2352x1568.
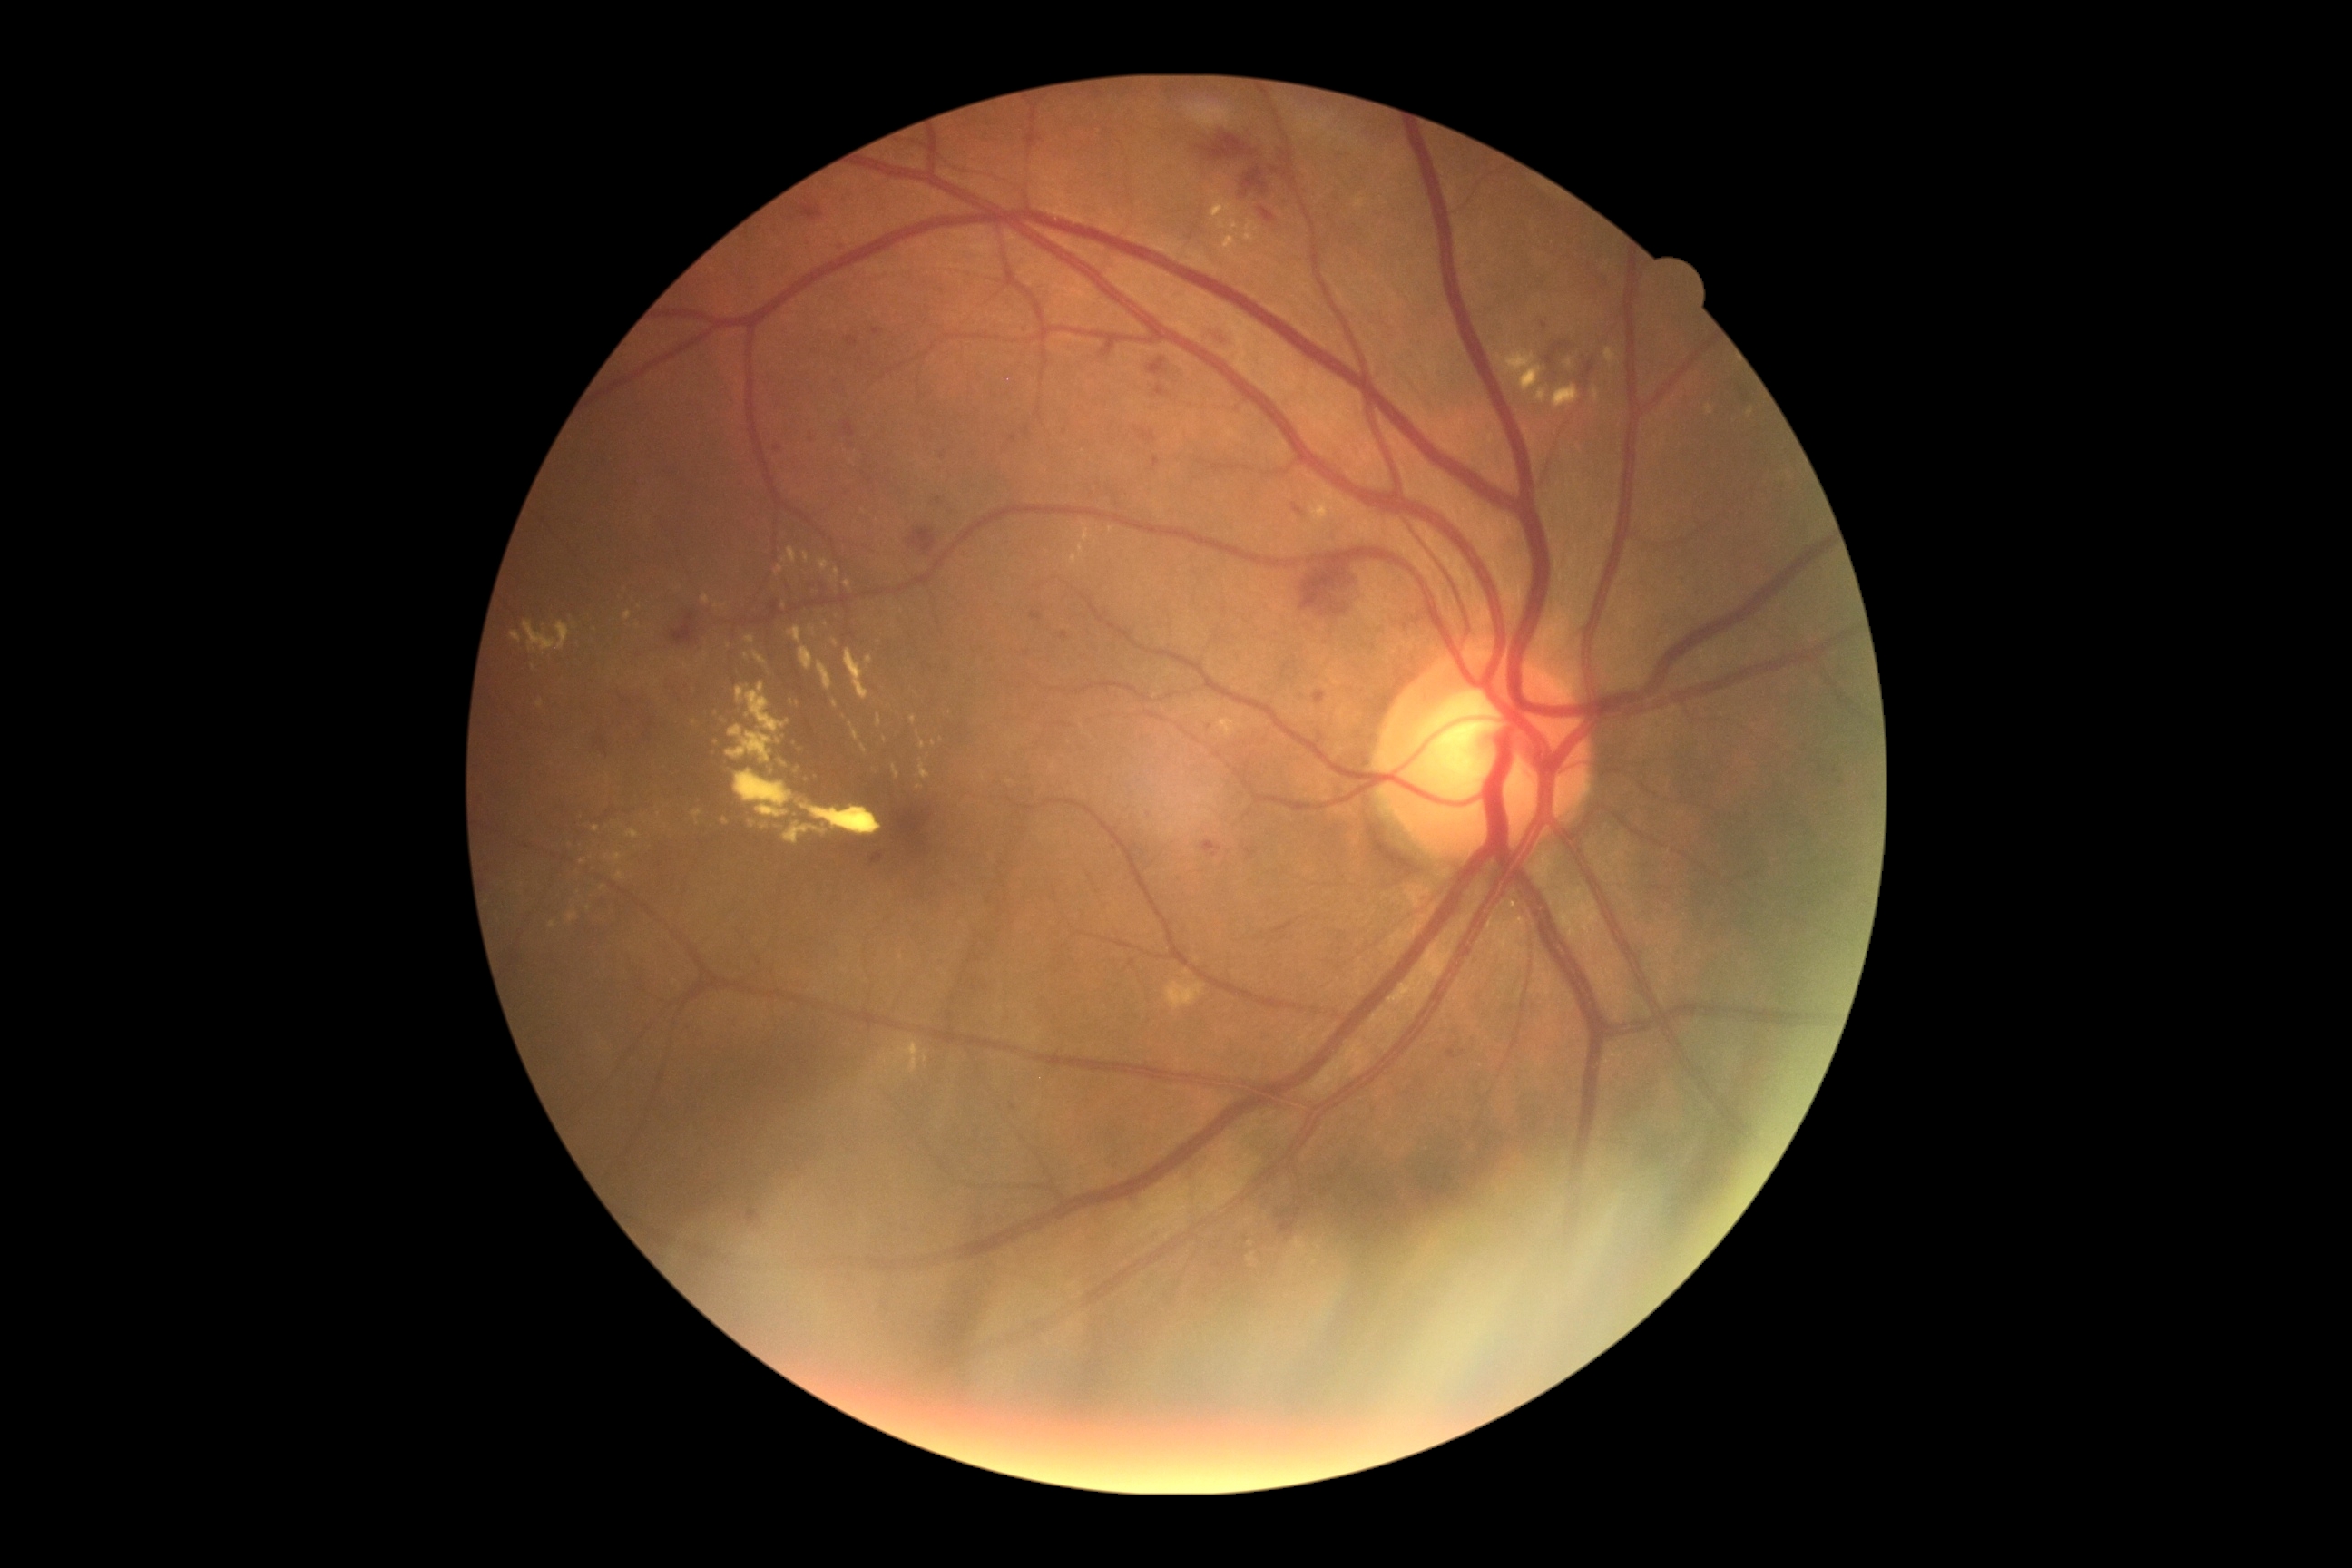 partial: true
dr_grade: 2
dr_grade_name: moderate NPDR
lesions:
  ex:
    - {"x1": 1224, "y1": 721, "x2": 1233, "y2": 734}
    - {"x1": 692, "y1": 810, "x2": 703, "y2": 827}
    - {"x1": 819, "y1": 560, "x2": 830, "y2": 573}
    - {"x1": 808, "y1": 627, "x2": 816, "y2": 634}
    - {"x1": 1079, "y1": 545, "x2": 1084, "y2": 558}
    - {"x1": 524, "y1": 622, "x2": 571, "y2": 654}
    - {"x1": 845, "y1": 580, "x2": 850, "y2": 591}
    - {"x1": 1318, "y1": 513, "x2": 1328, "y2": 522}
    - {"x1": 818, "y1": 662, "x2": 832, "y2": 691}
    - {"x1": 789, "y1": 625, "x2": 803, "y2": 643}
    - {"x1": 1248, "y1": 1253, "x2": 1257, "y2": 1264}
  ex_small:
    - x=942, y=741
    - x=583, y=862
    - x=826, y=625
    - x=602, y=888
    - x=640, y=607
    - x=1249, y=236